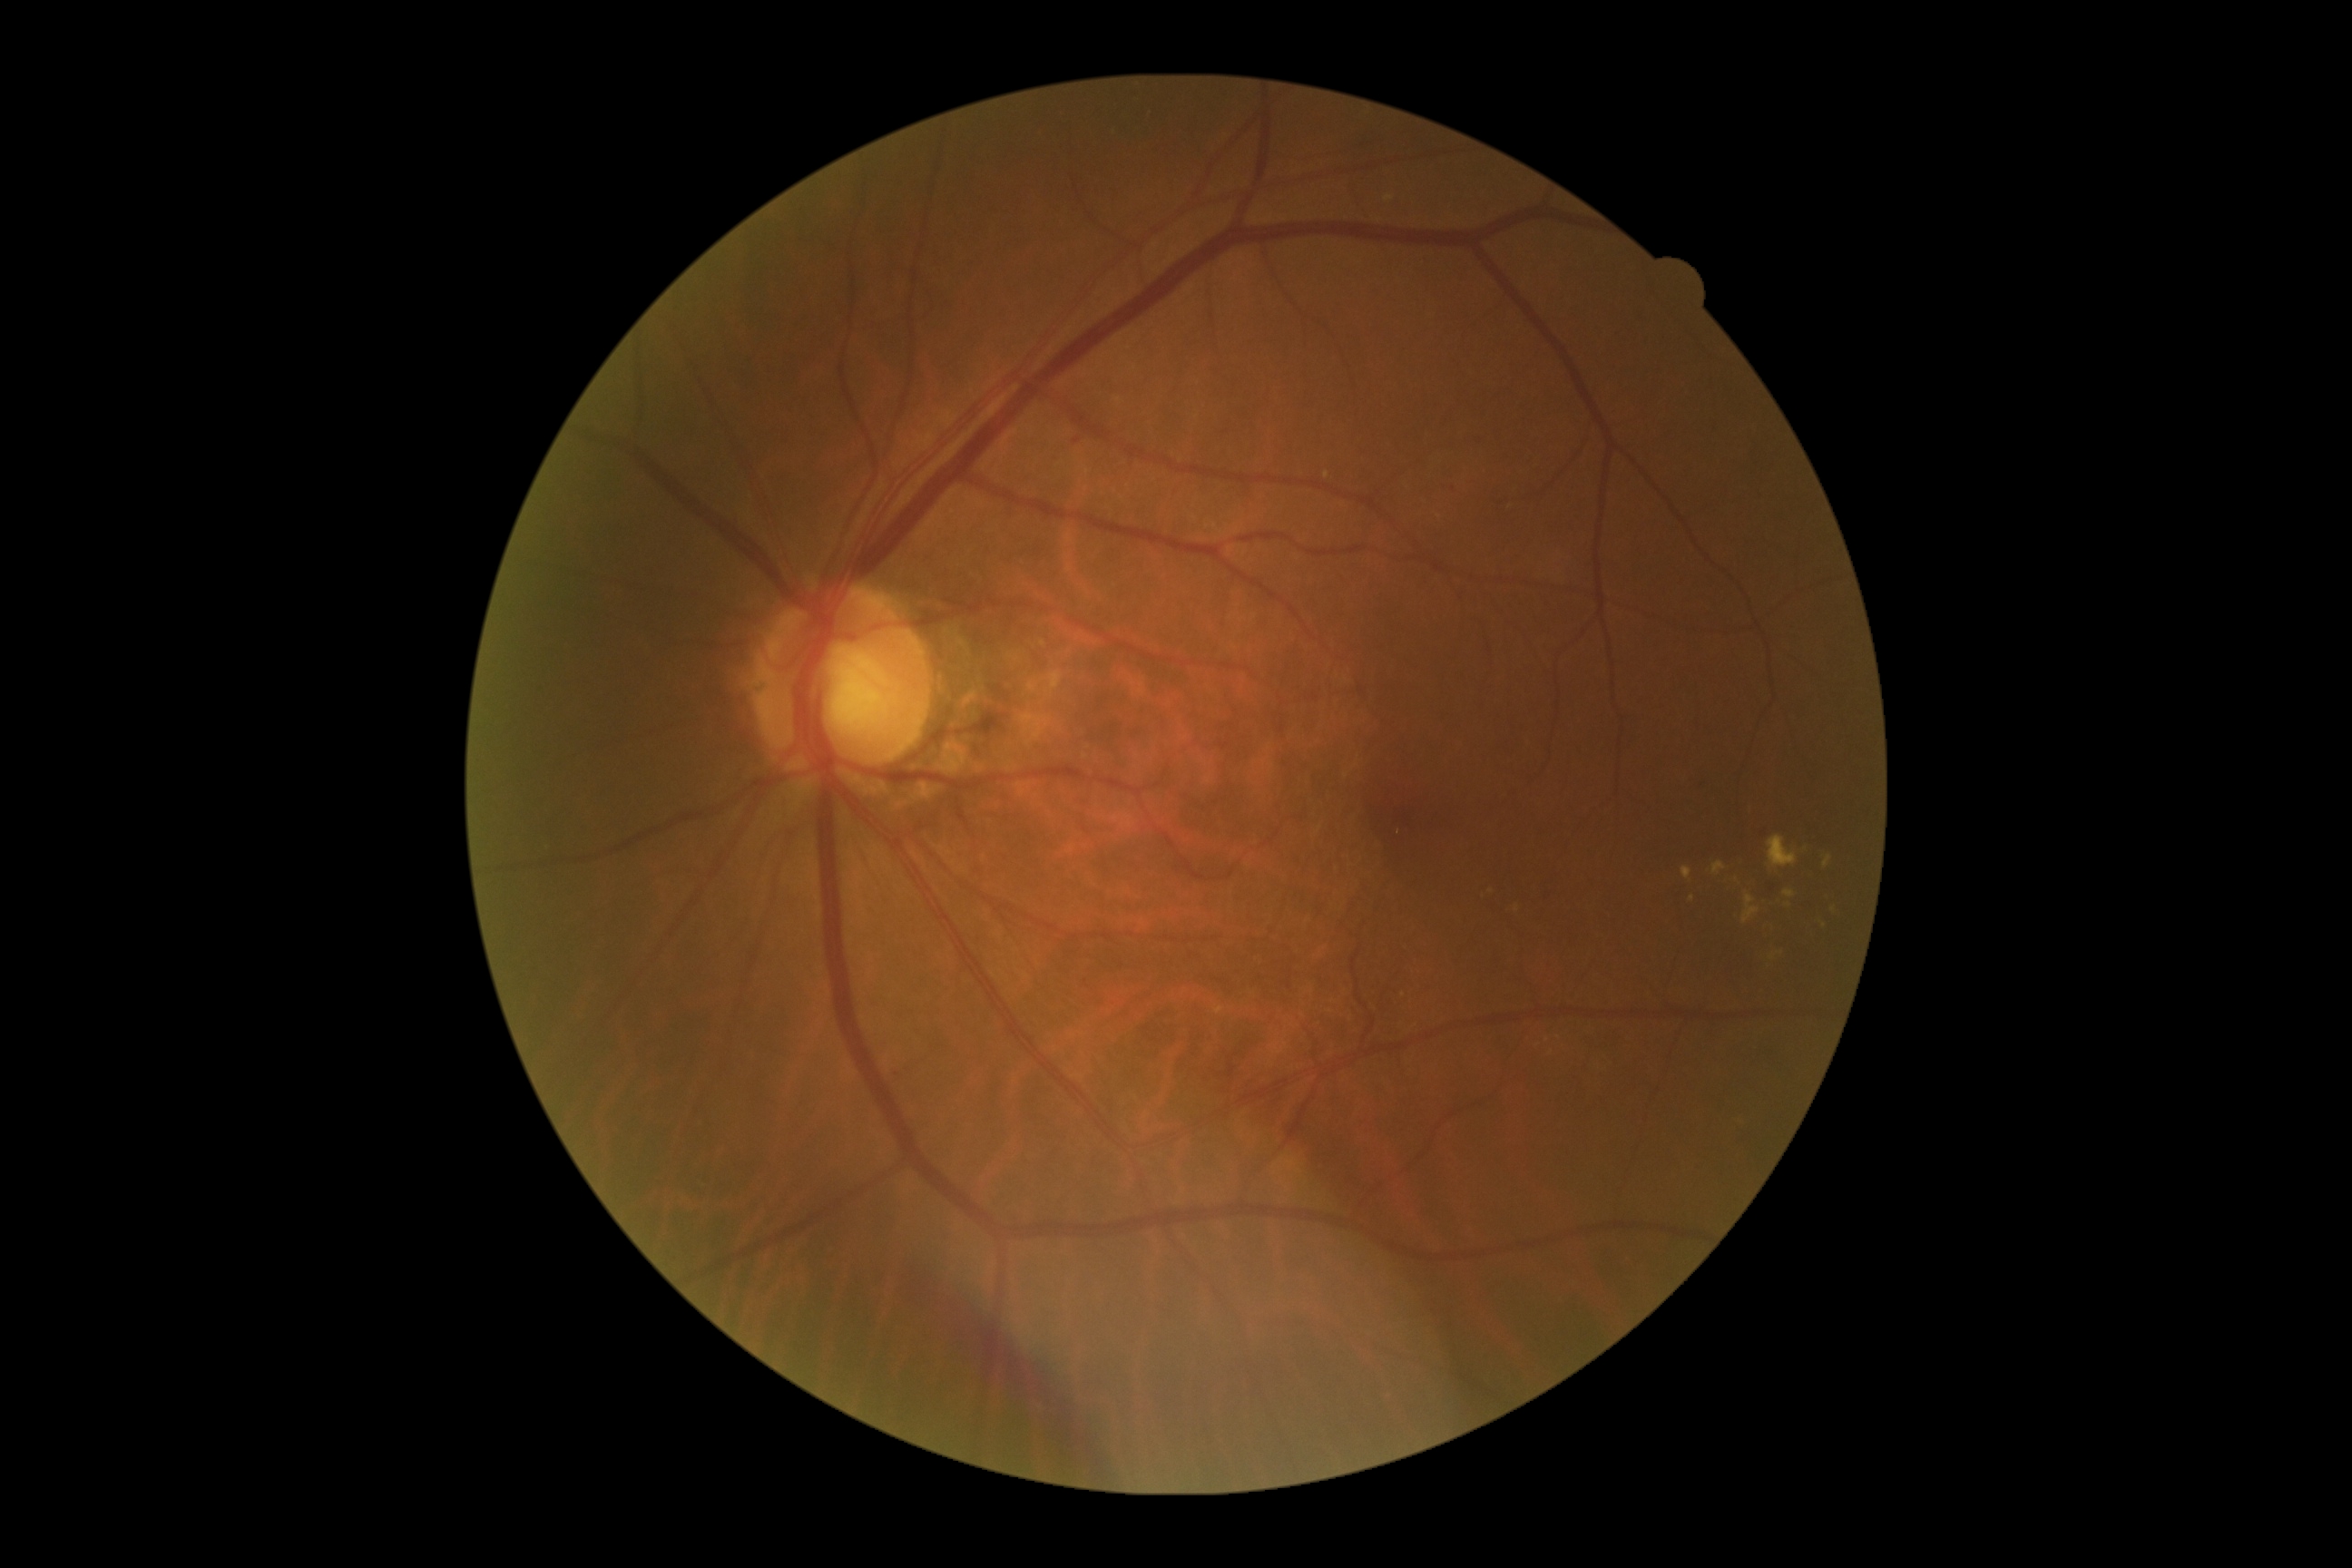 DR stage=grade 2 — more than just microaneurysms but less than severe NPDR.